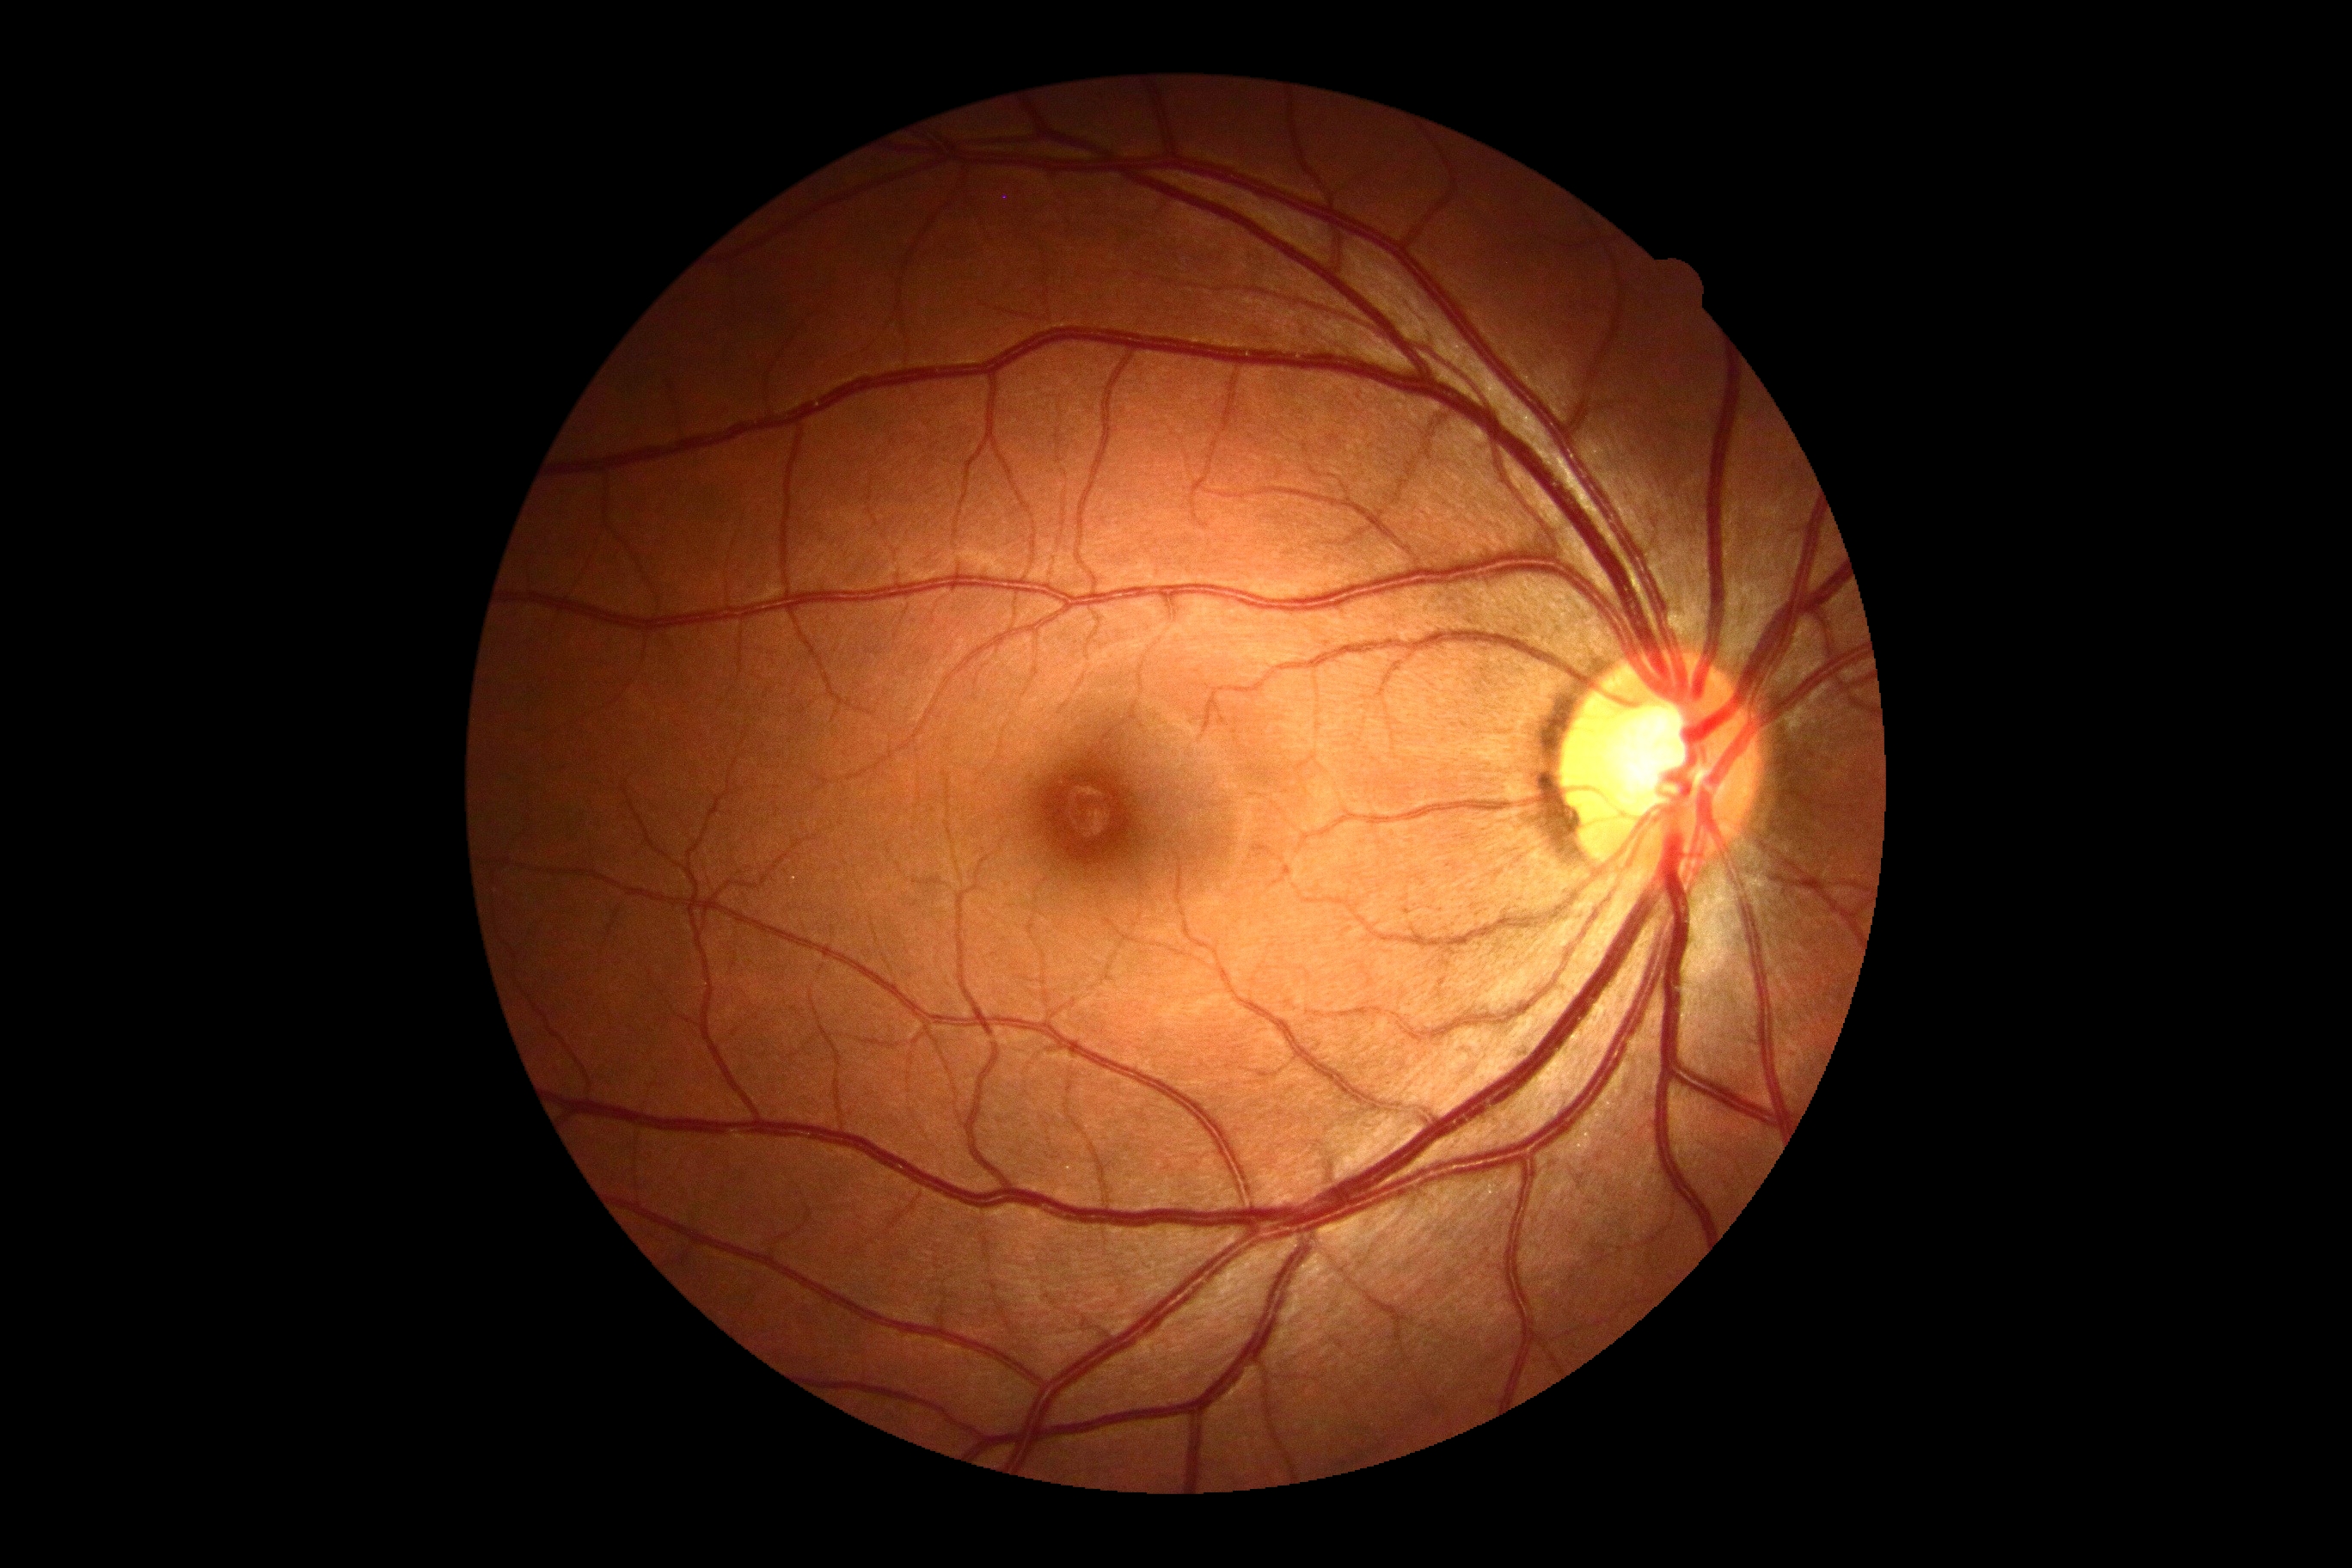

Diabetic retinopathy (DR): no apparent retinopathy (grade 0).